2368x1568px.
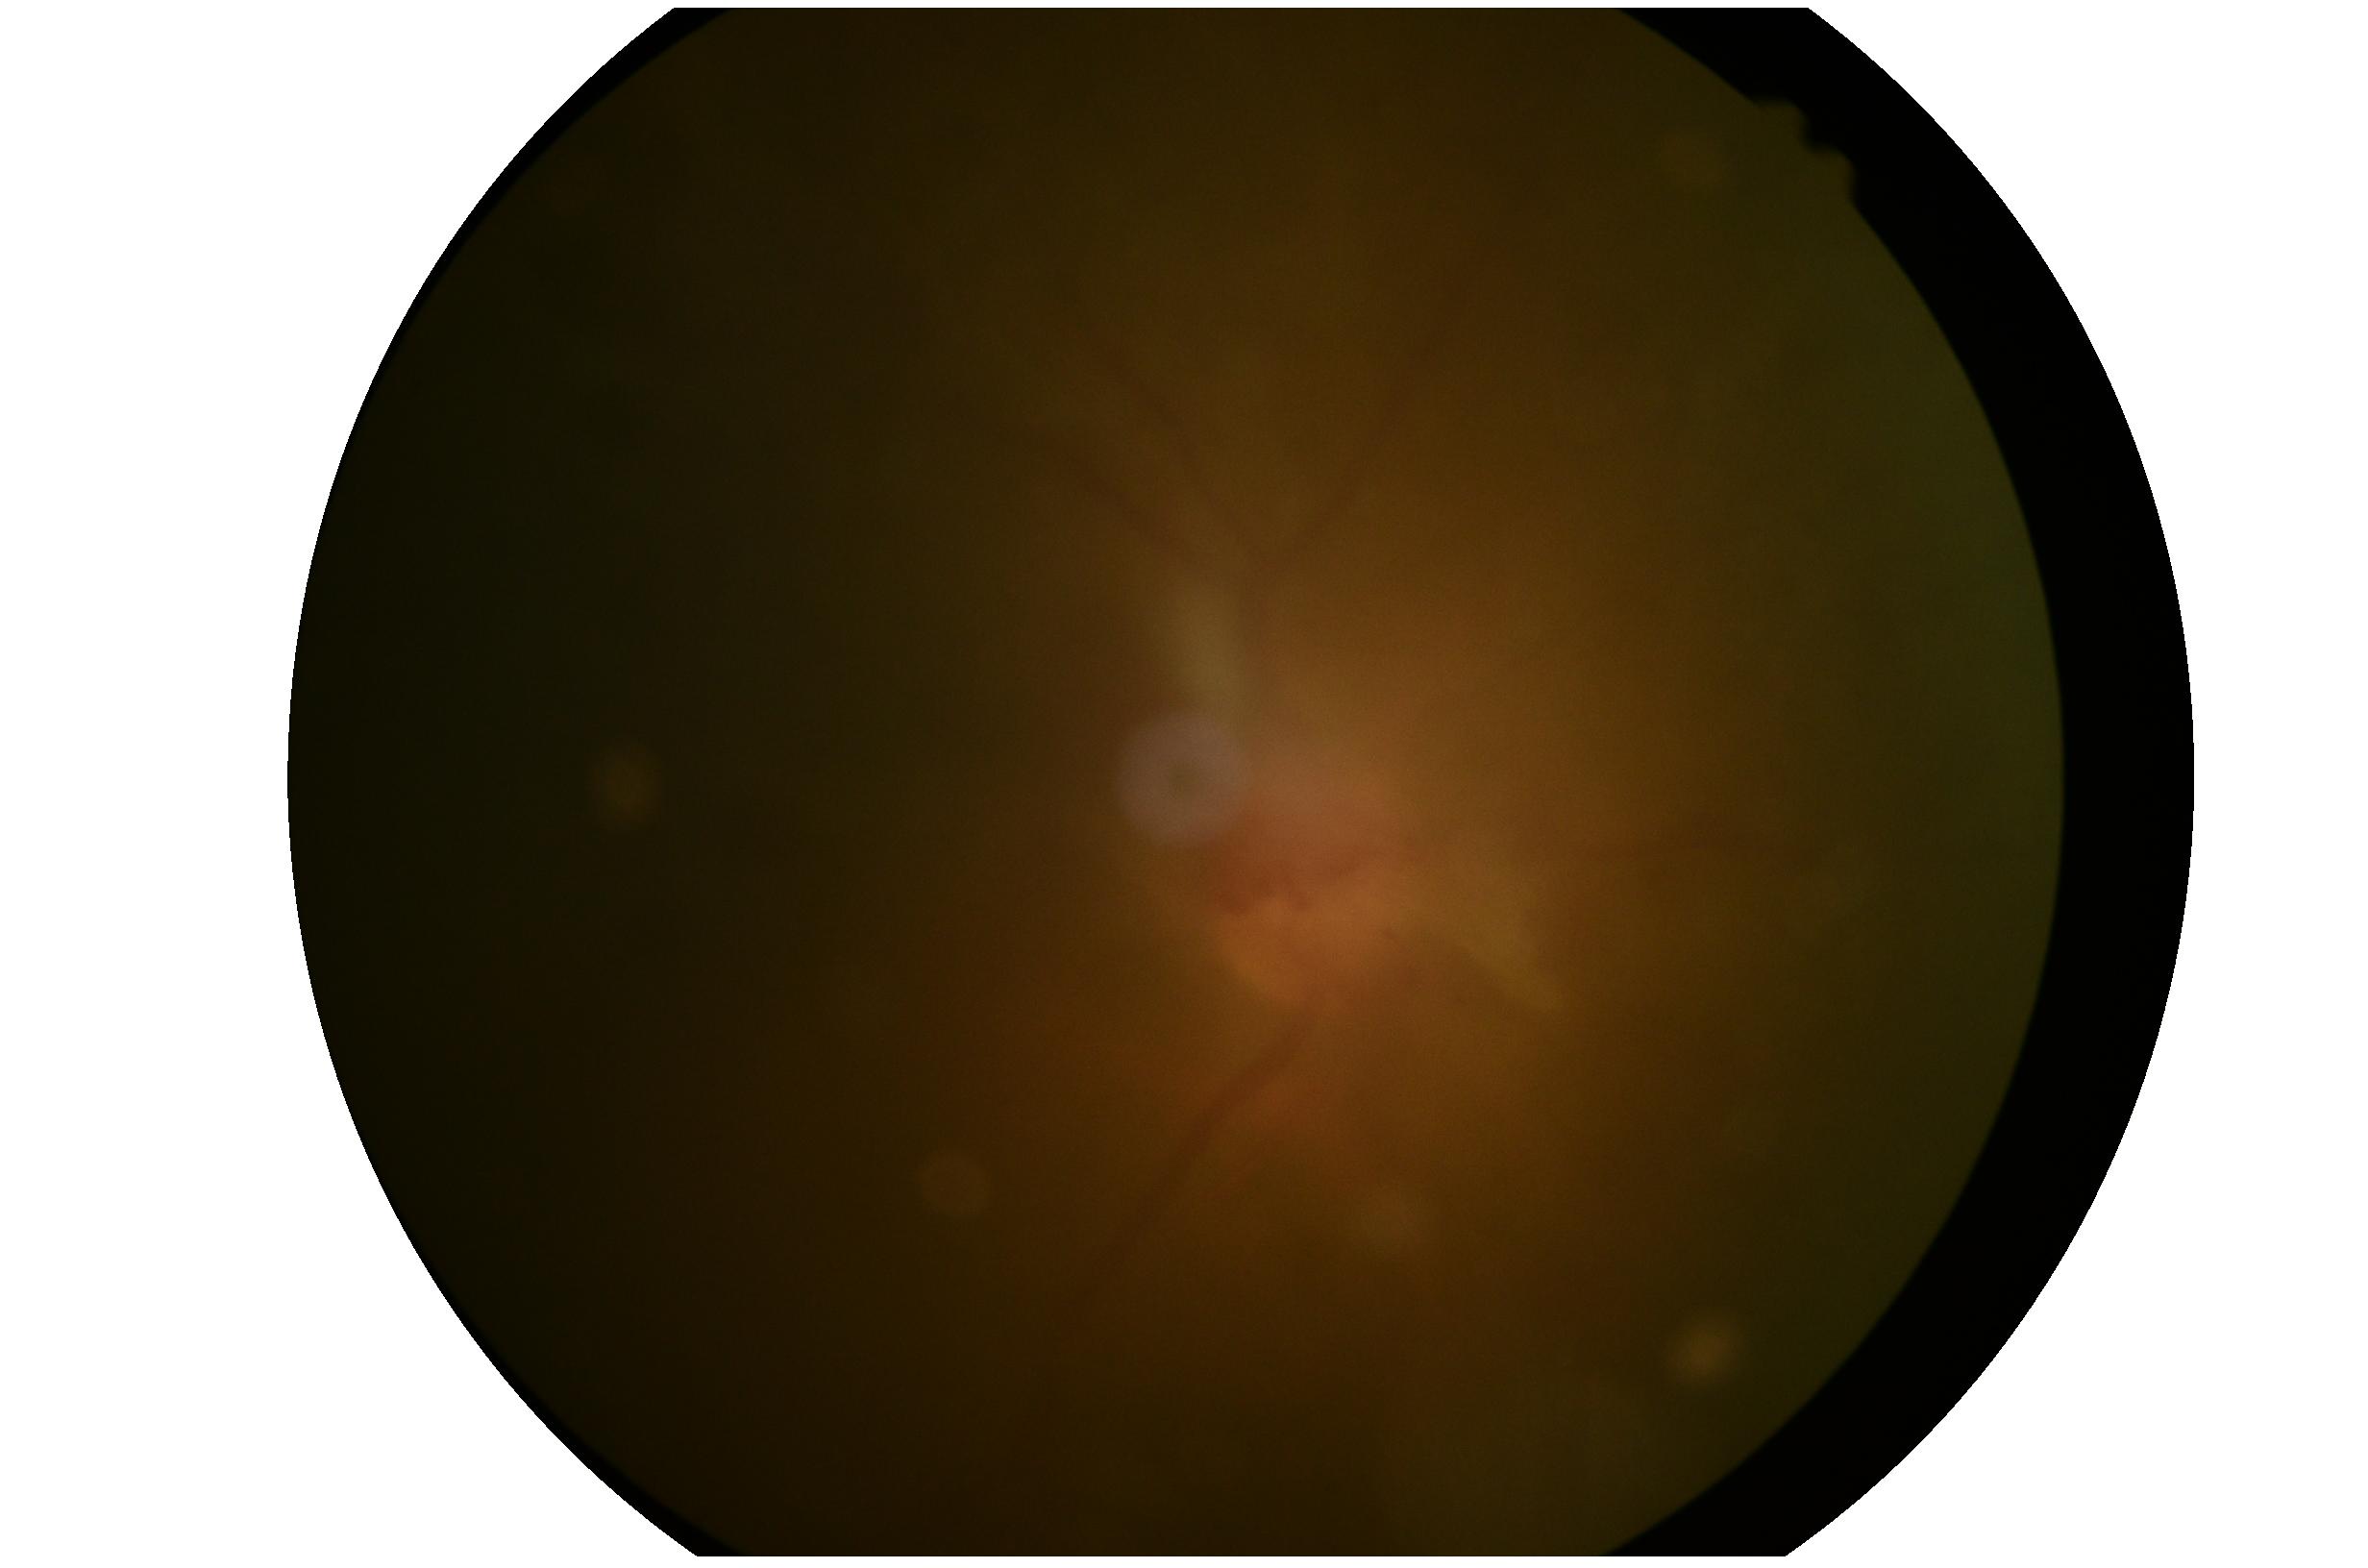

Diabetic retinopathy (DR) is PDR (grade 4).